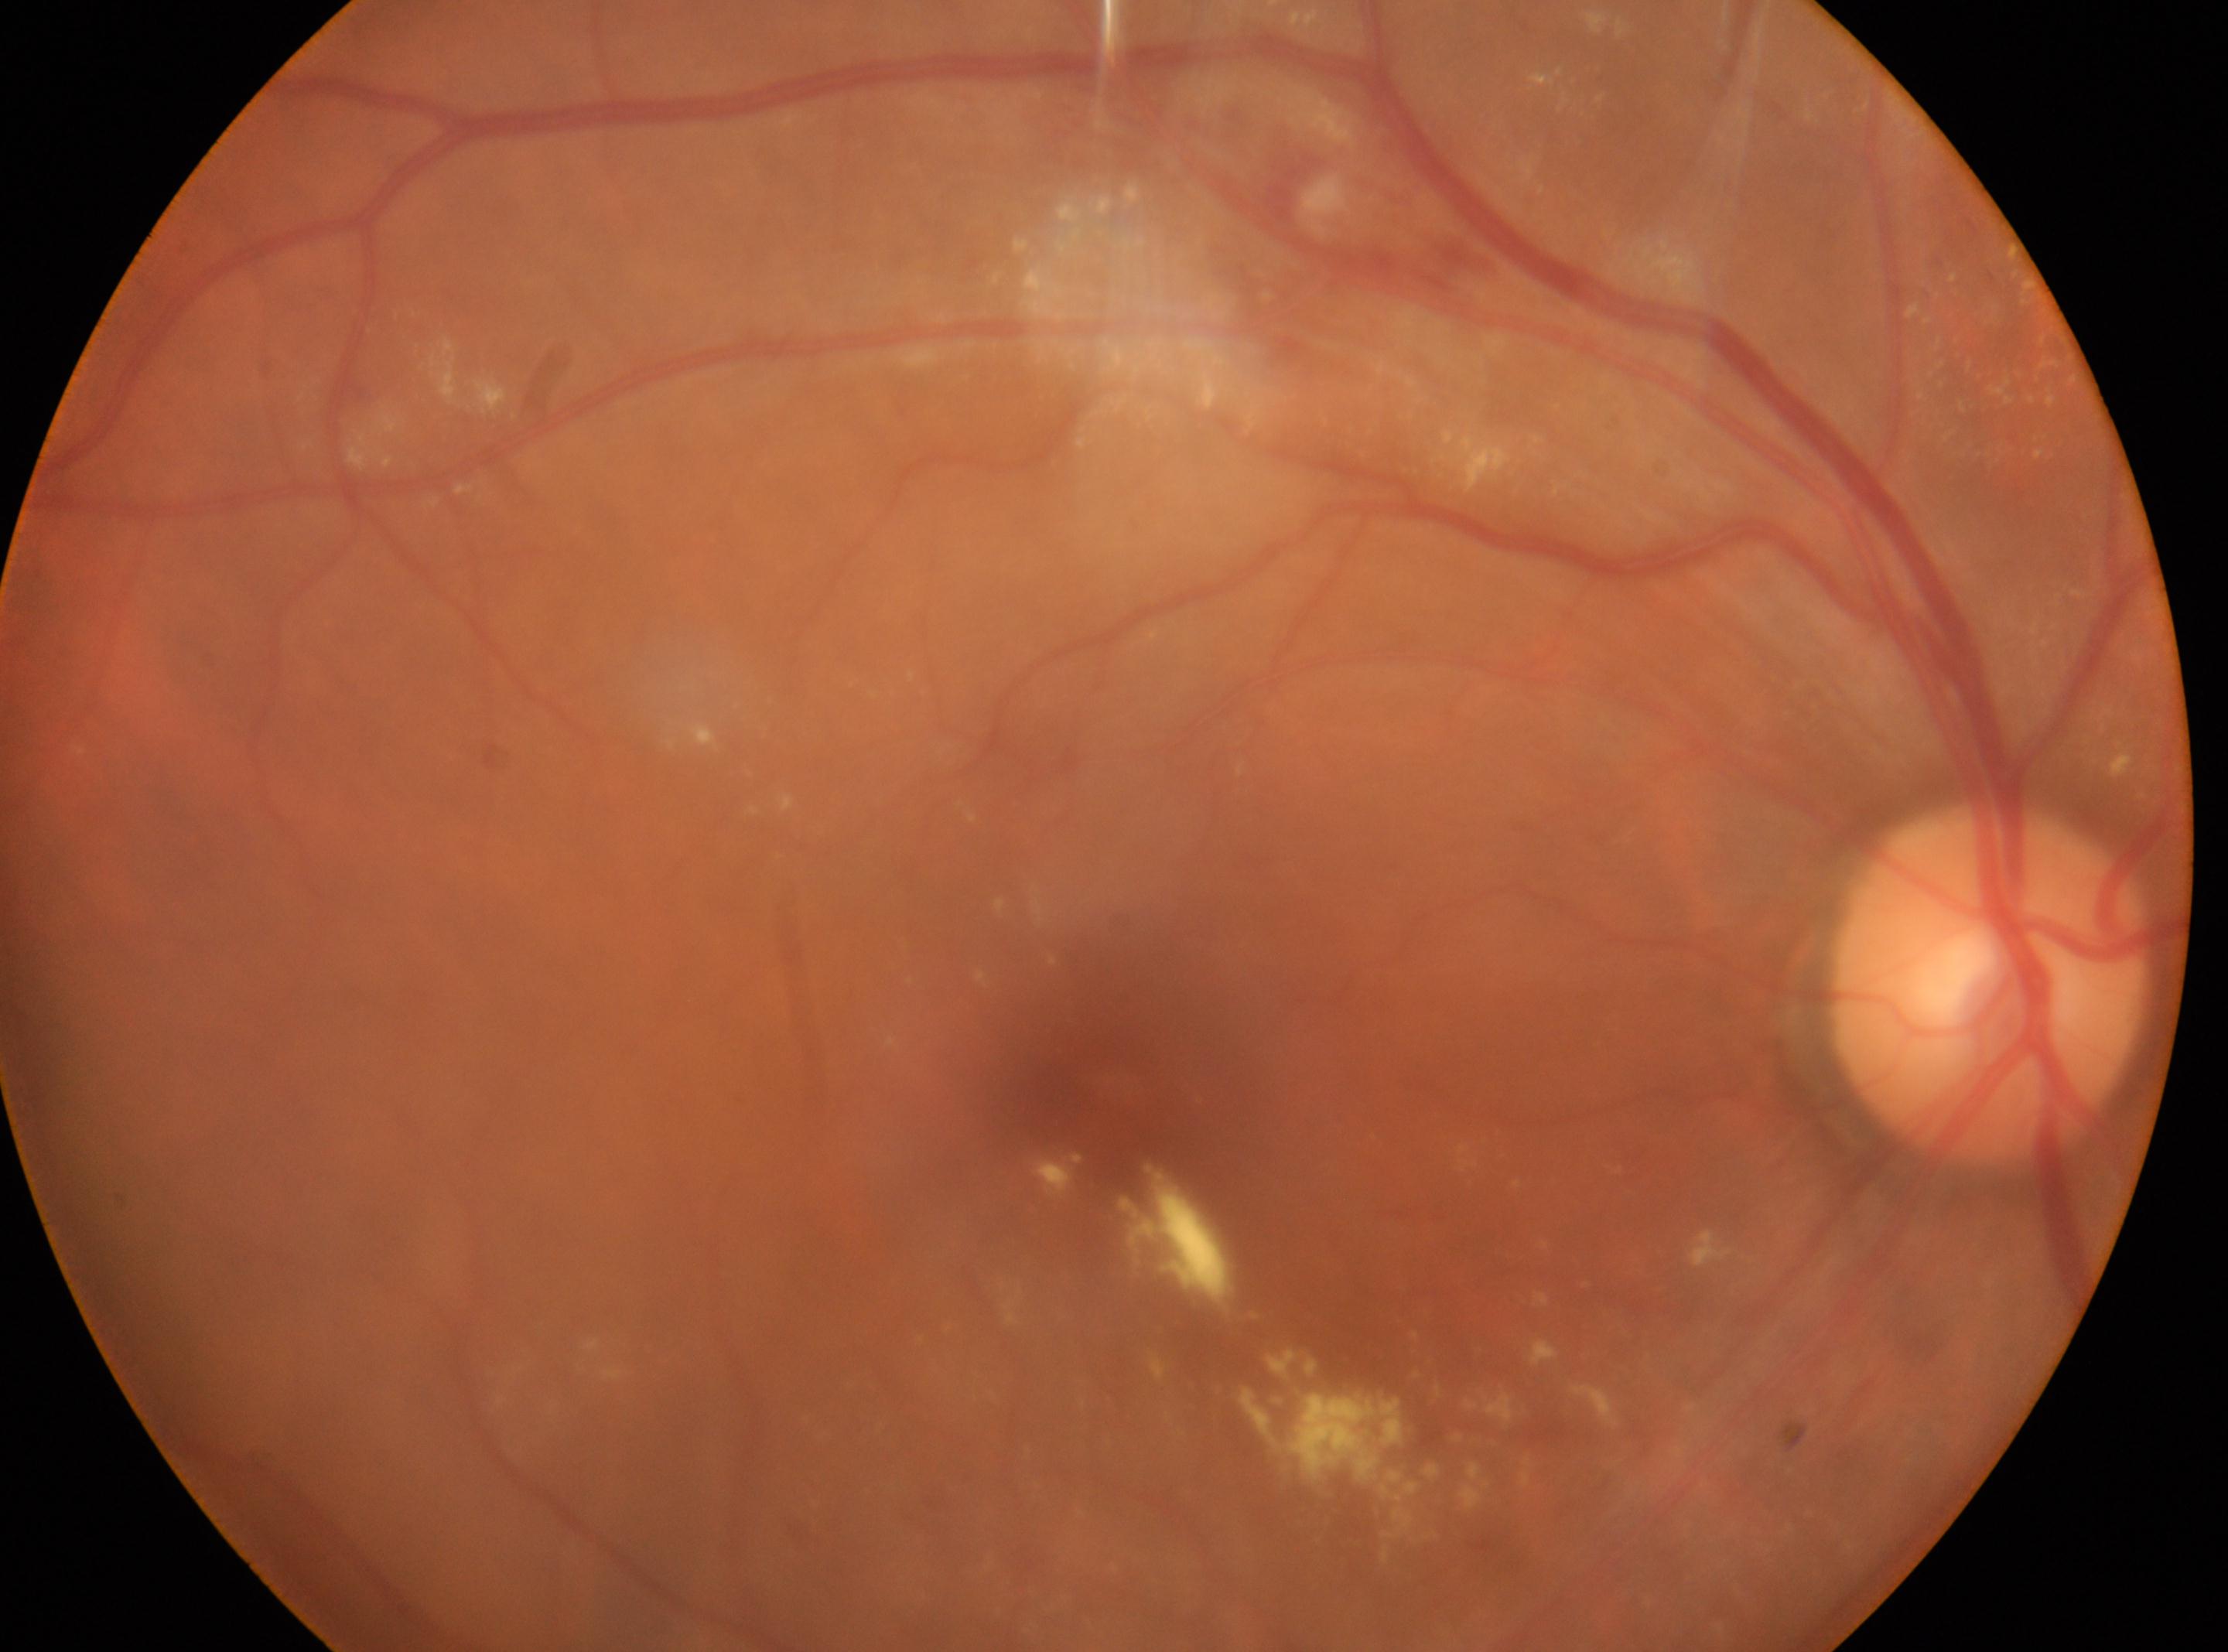

the right eye | foveal center@1106px, 1084px | disc center@1987px, 983px | DR grade@moderate NPDR (2).